Mydriatic (tropicamide and phenylephrine); retinal fundus photograph.
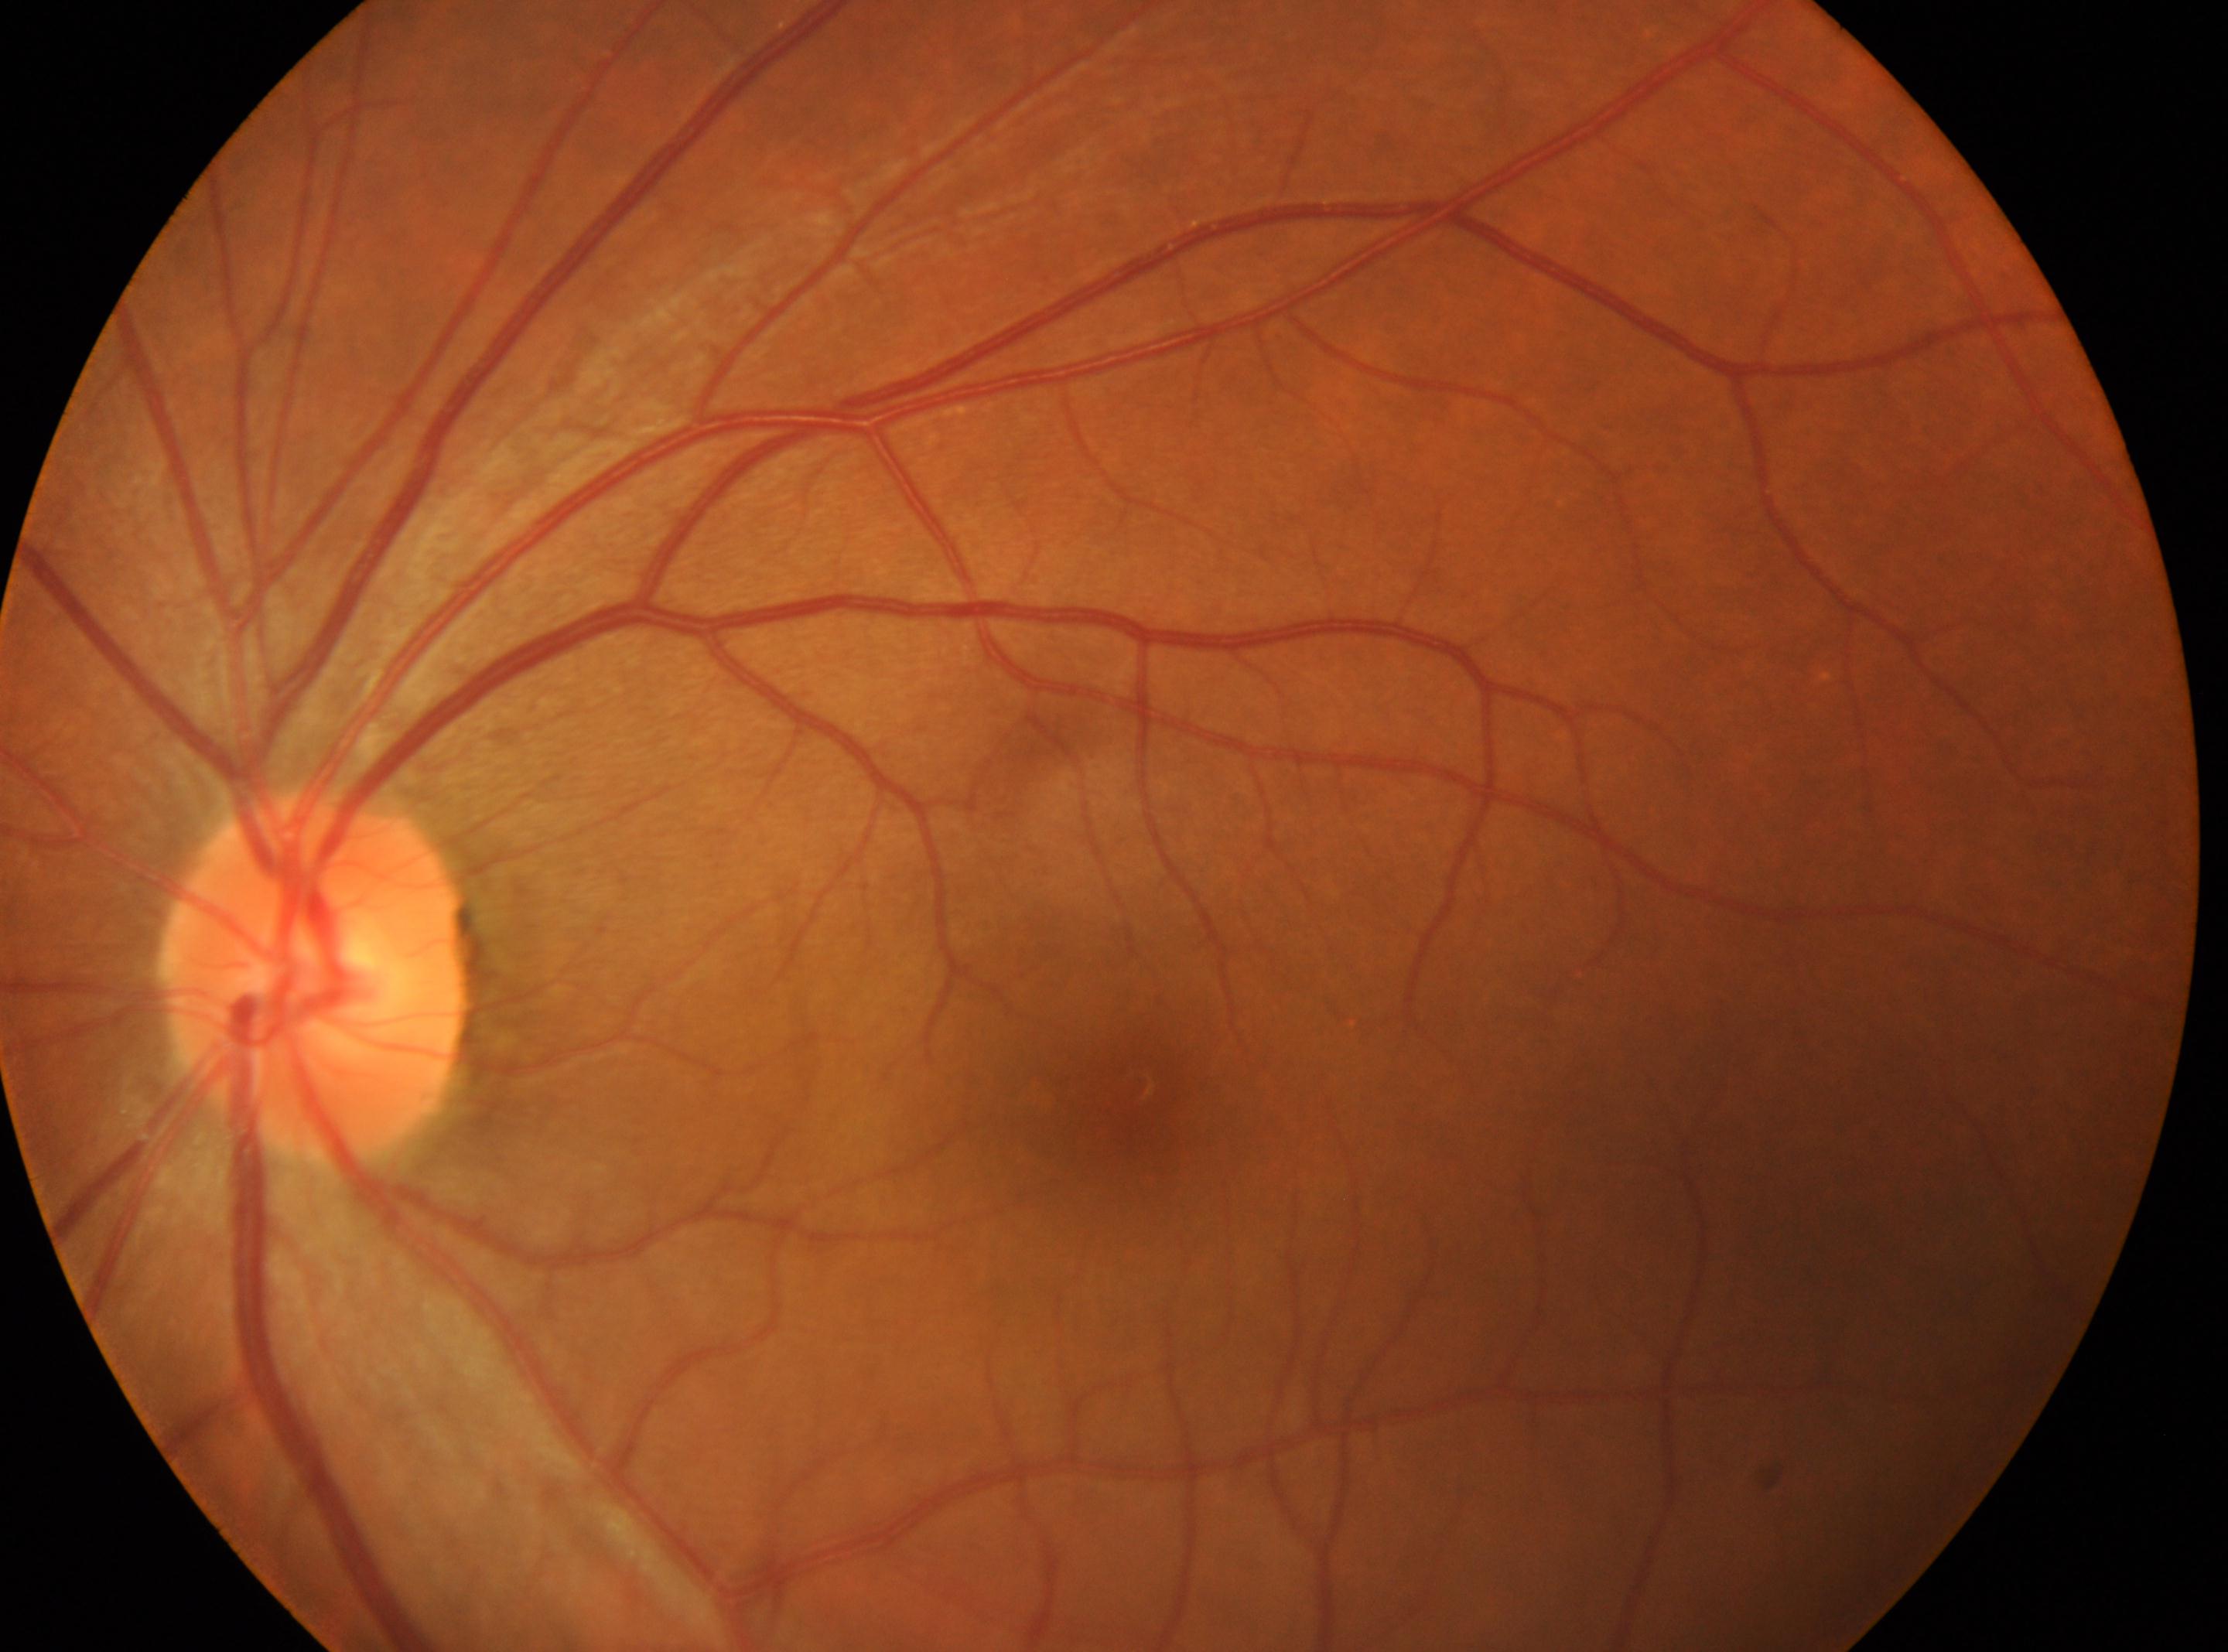

| feature | annotation |
|---|---|
| the fovea | 1129px, 1103px |
| optic disk | 313px, 981px |
| DR | no apparent retinopathy (grade 0) |
| DR impression | No diabetic retinopathy identified |
| laterality | left |